45° FOV, CFP, camera: NIDEK AFC-230
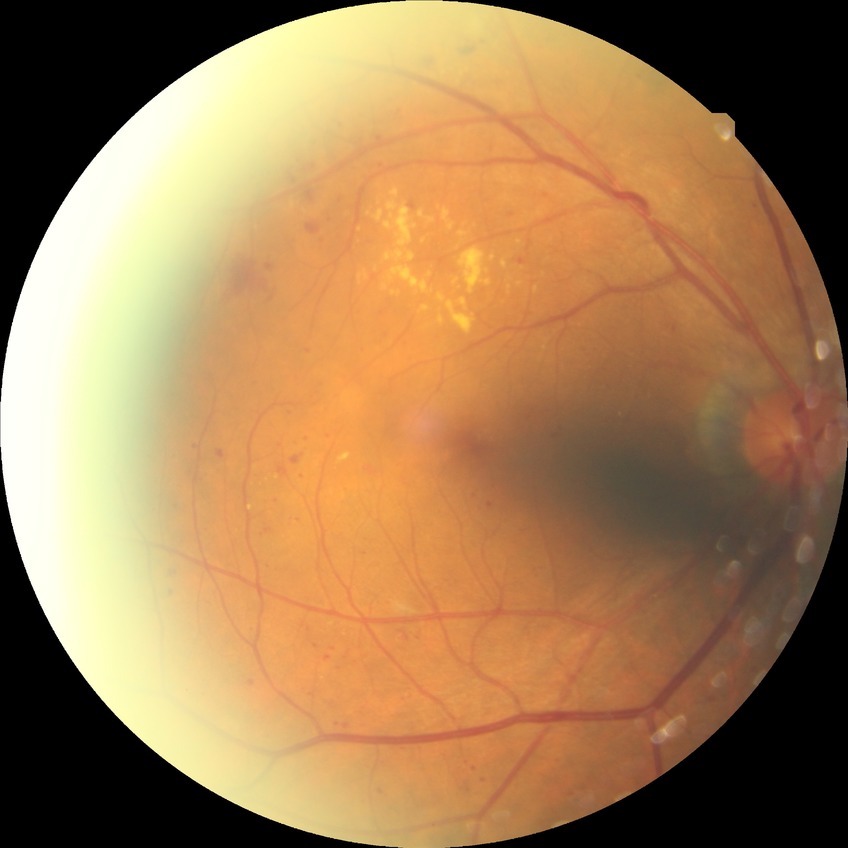
Retinopathy grade: simple diabetic retinopathy.
Disease class: non-proliferative diabetic retinopathy.